Nonmydriatic fundus photograph; camera: NIDEK AFC-230: 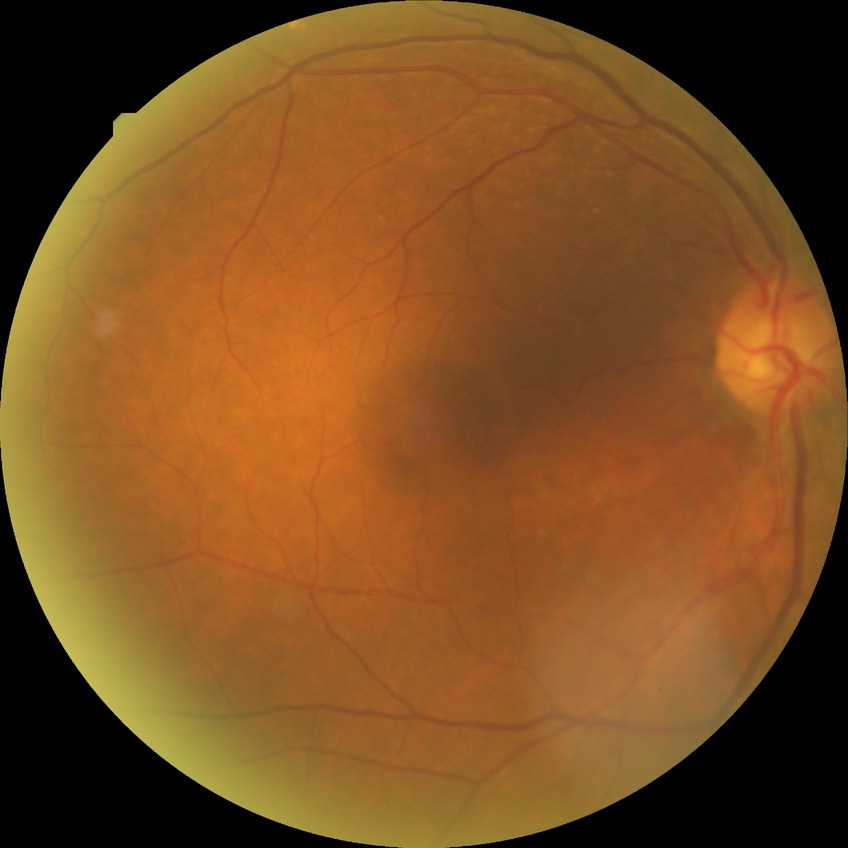
Diabetic retinopathy (DR): simple diabetic retinopathy (SDR).